45° FOV. Acquired with a NIDEK AFC-230. 848x848 — 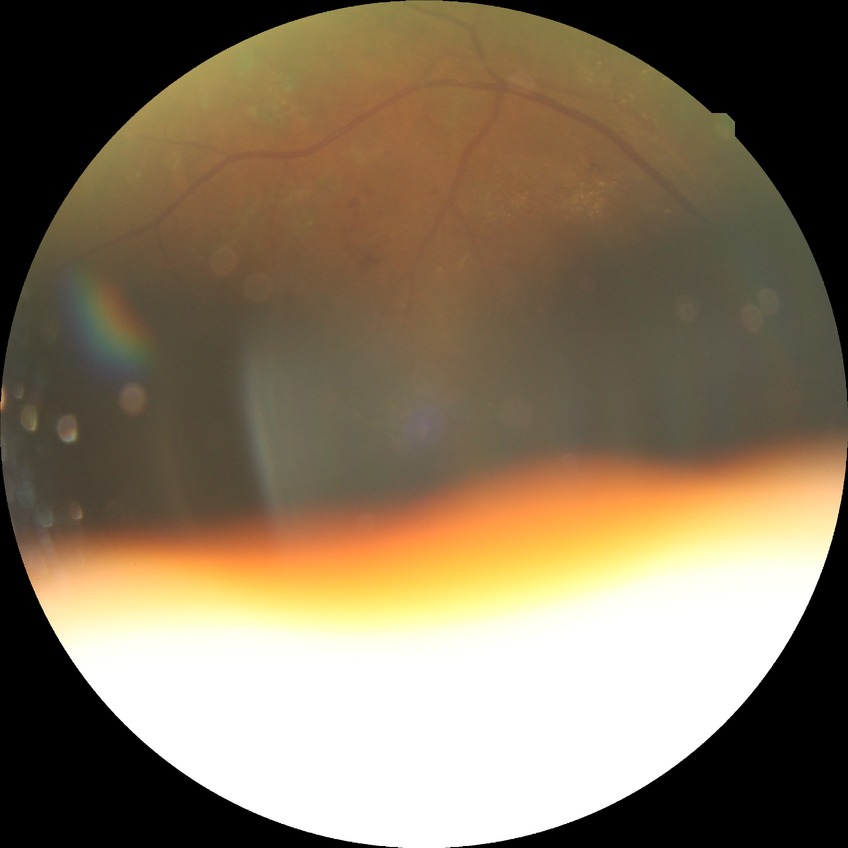 diabetic retinopathy (DR) = proliferative diabetic retinopathy (PDR).